Image size 848x848 · graded on the modified Davis scale: 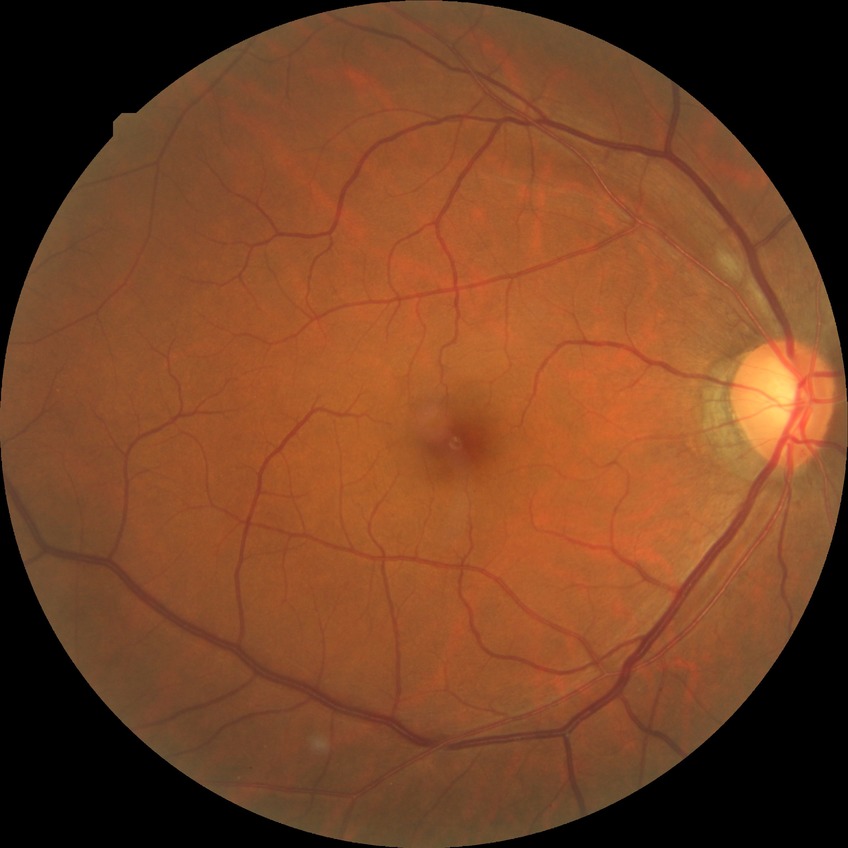

Findings:
* diabetic retinopathy (DR): NDR (no diabetic retinopathy)